Tabletop color fundus camera image.
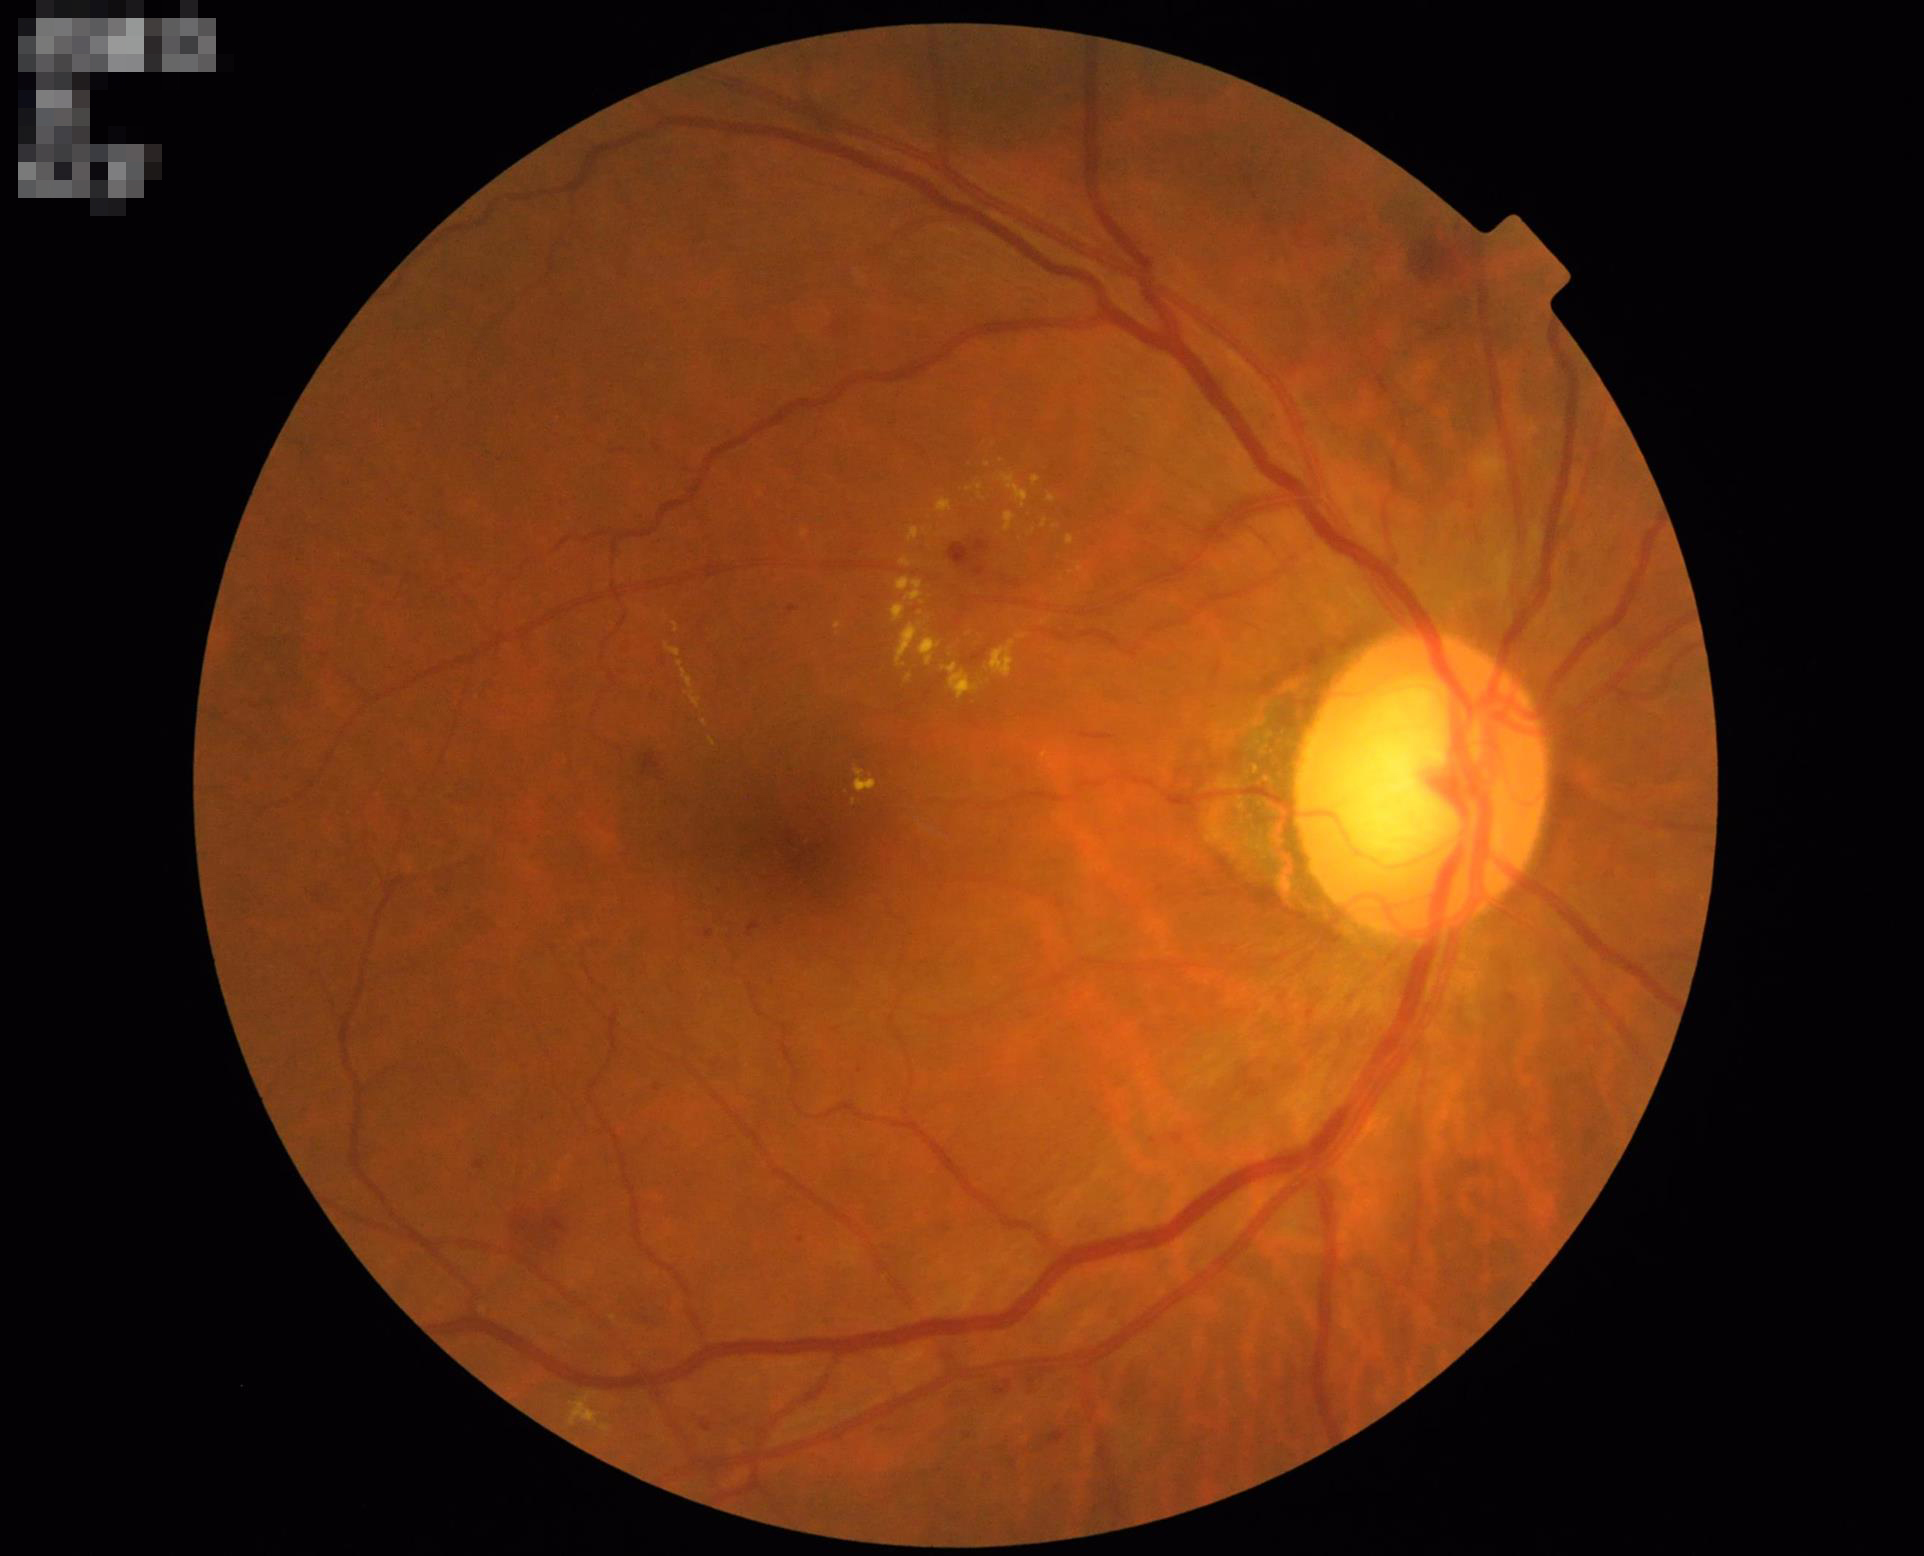

Even illumination with no color cast. Acceptable image quality. Optic disc, vessels, and background are in focus. Good dynamic range.